Camera: Clarity RetCam 3 (130° FOV). Pediatric wide-field fundus photograph.
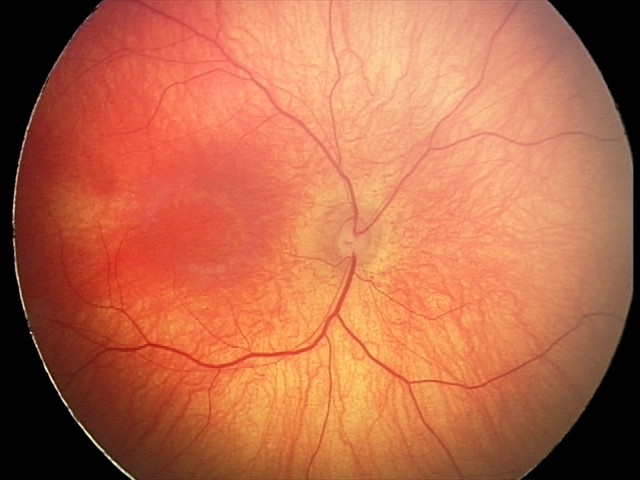
Finding = physiological appearance.